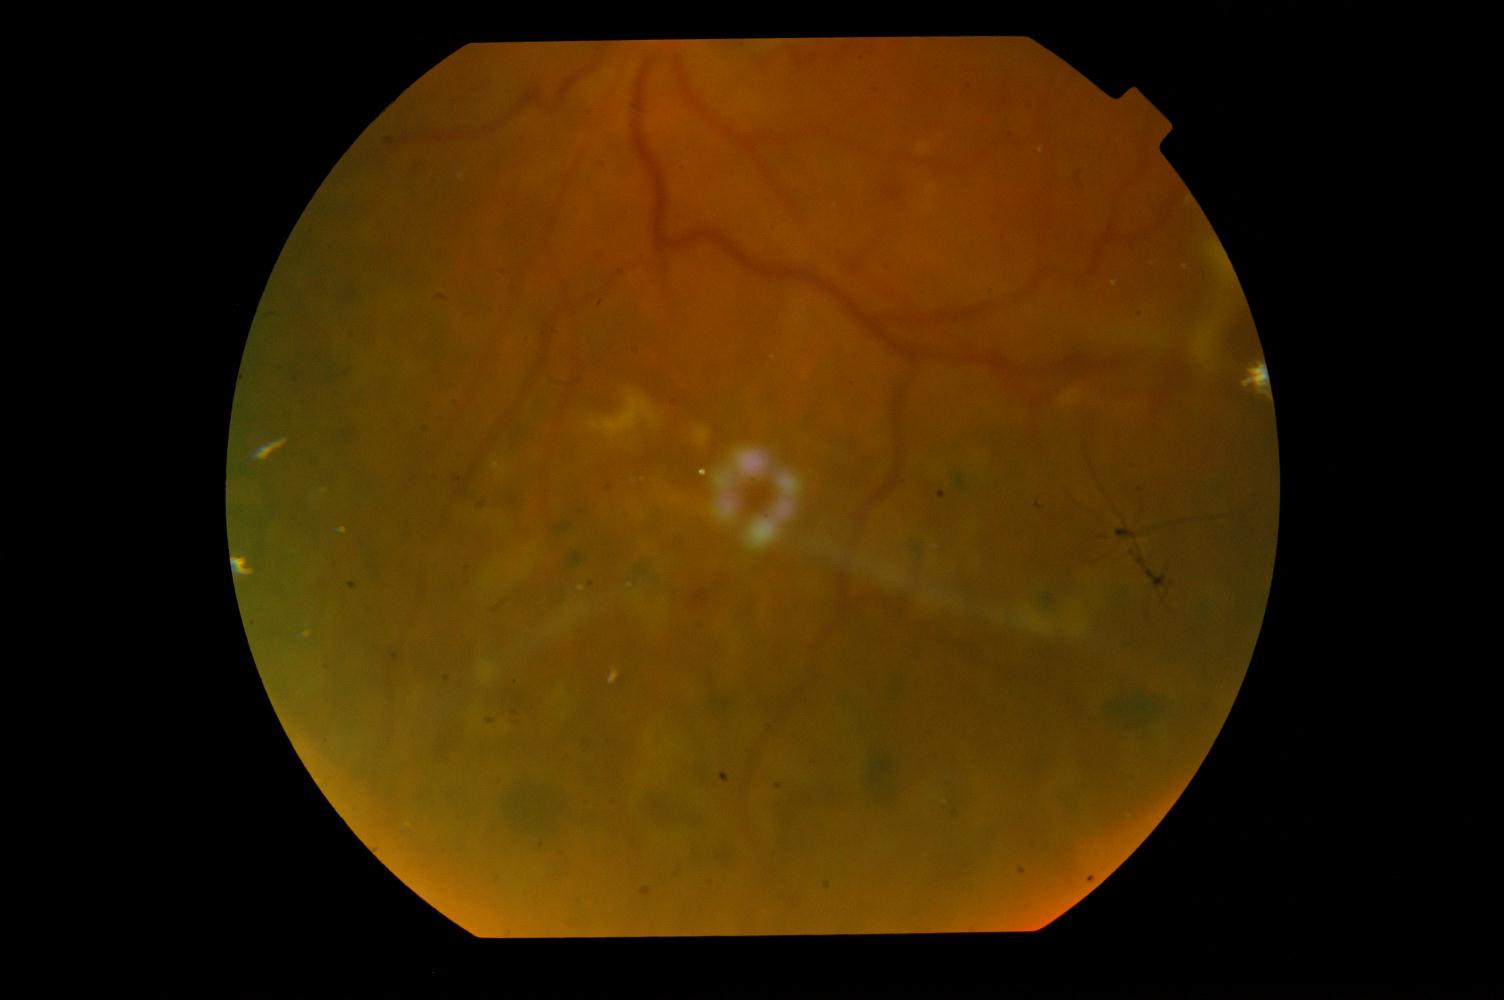
The image shows diabetic retinopathy.